1240 x 1240 pixels; wide-field fundus photograph from neonatal ROP screening; Phoenix ICON, 100° FOV — 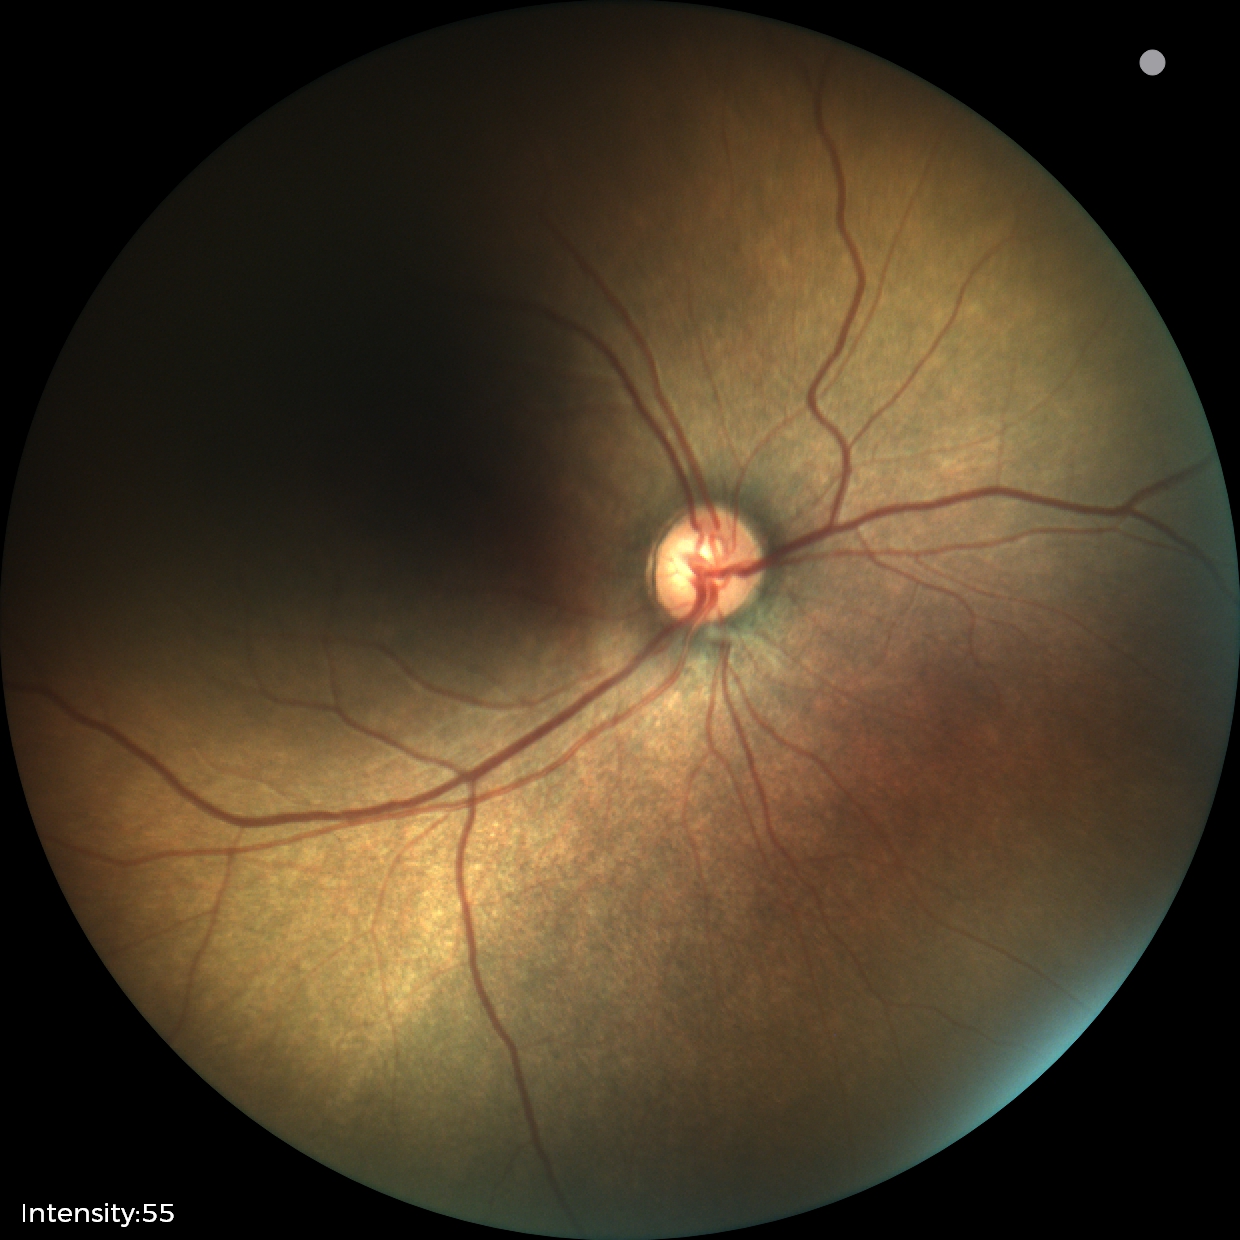

Without plus disease. From an examination with diagnosis of status post retinopathy of prematurity (ROP).